640x480 · pediatric retinal photograph (wide-field) · Clarity RetCam 3, 130° FOV
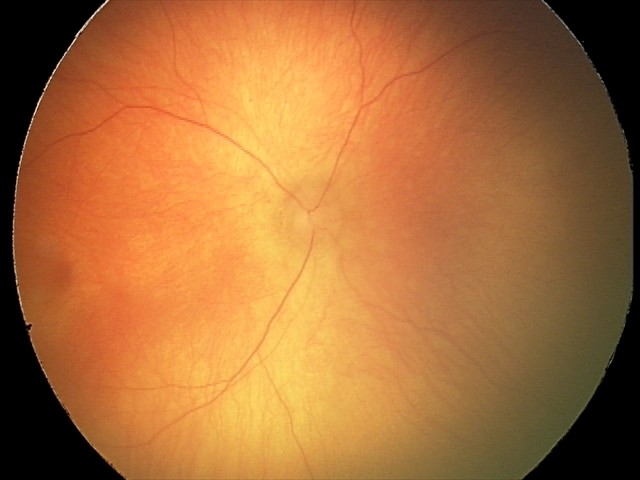
Screening series with ROP stage 0.
No plus disease.